130° field of view (Clarity RetCam 3); 640 by 480 pixels; pediatric retinal photograph (wide-field) — 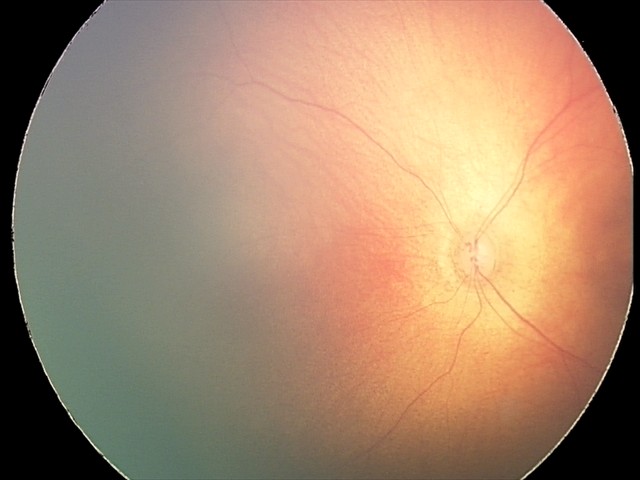

Screening diagnosis: retinal hemorrhages.